Infant wide-field retinal image · 640x480:
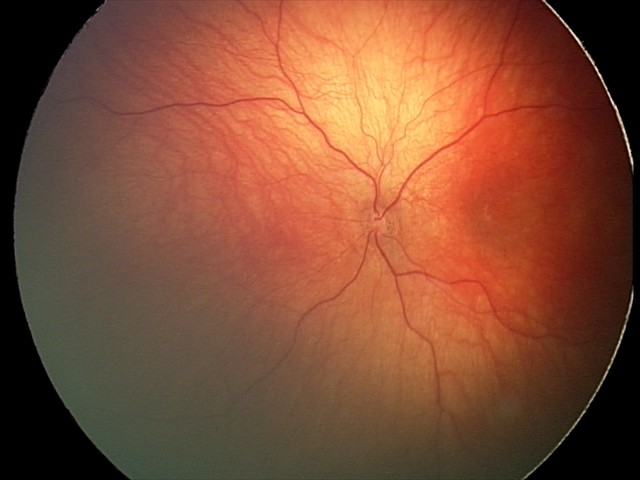 Screening: physiological finding.